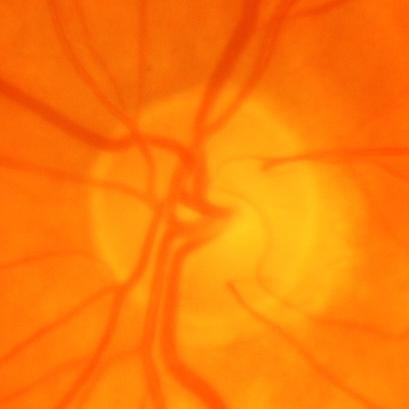
Diagnosis = glaucomatous changes.